Modified Davis classification:
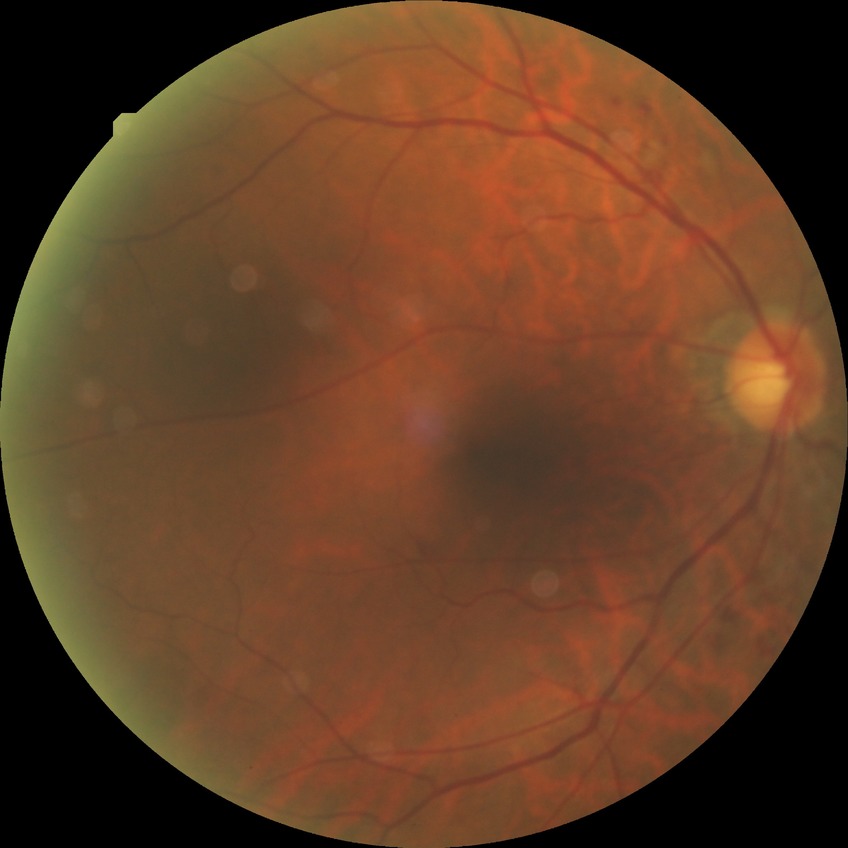 Modified Davis grading: simple diabetic retinopathy. DR class: non-proliferative diabetic retinopathy.